Camera: Nidek AFC-330; CFP; centered on the optic disc:
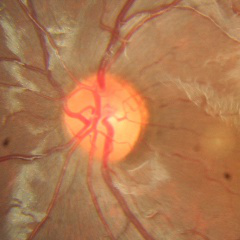 Showing no glaucomatous optic neuropathy.